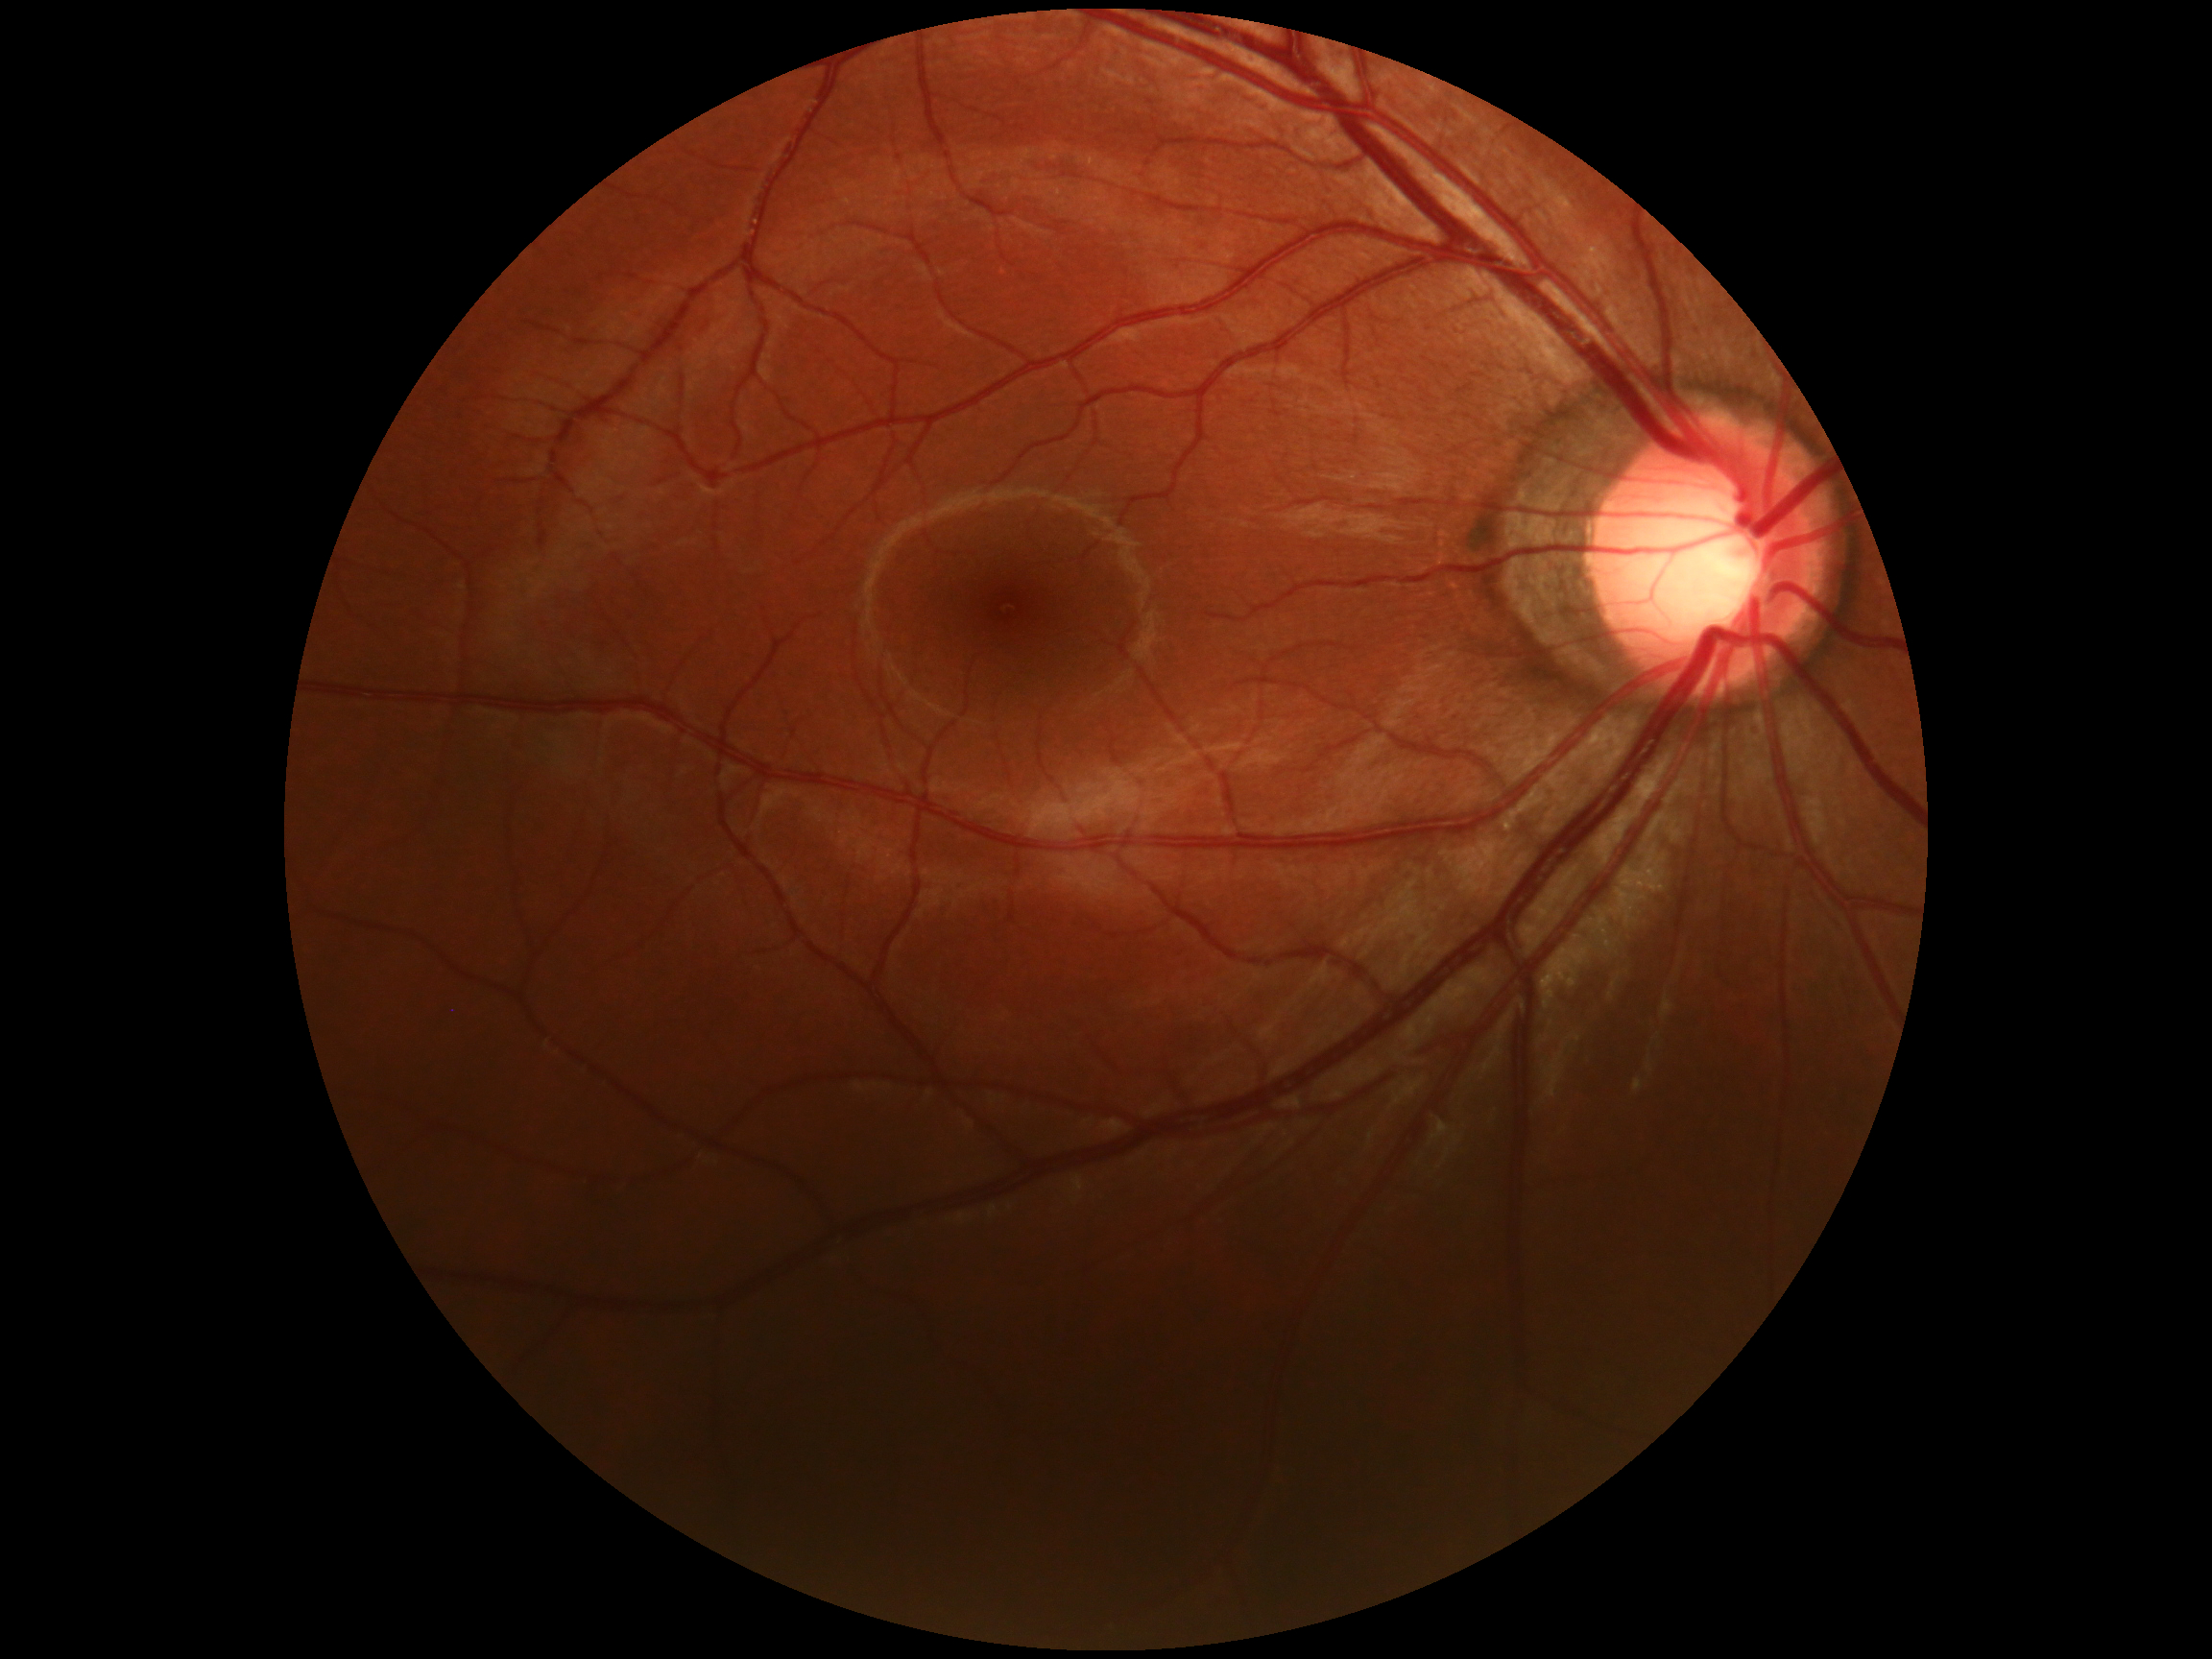
* diabetic retinopathy grade: 0 — no visible signs of diabetic retinopathy